848x848 · acquired with a NIDEK AFC-230
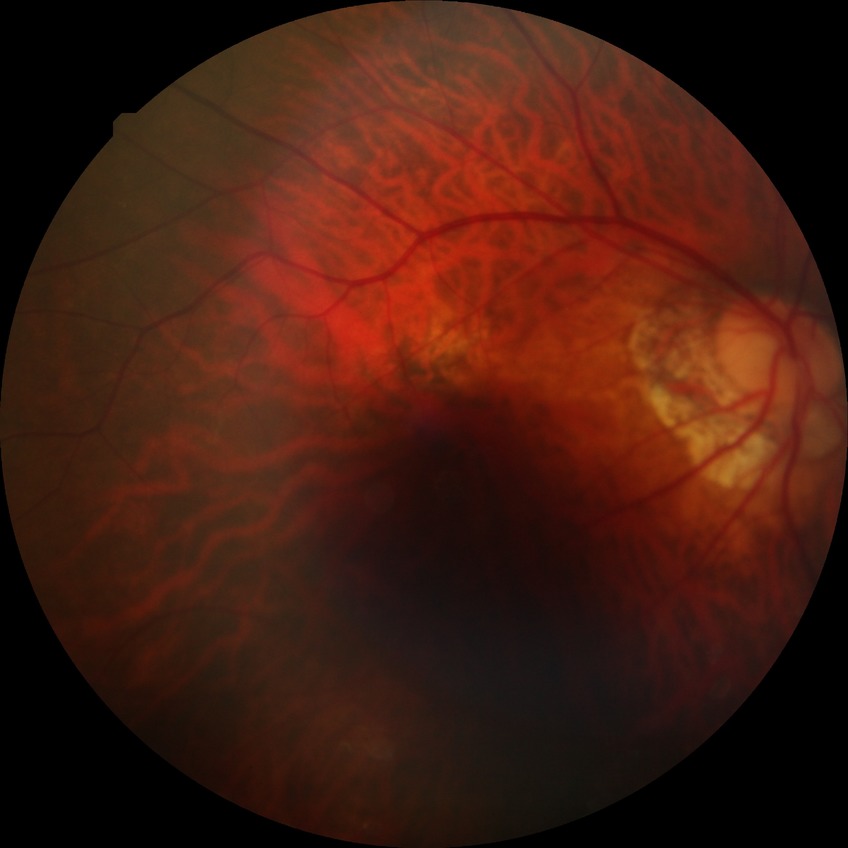

Diabetic retinopathy severity is no diabetic retinopathy.